Wide-field contact fundus photograph of an infant:
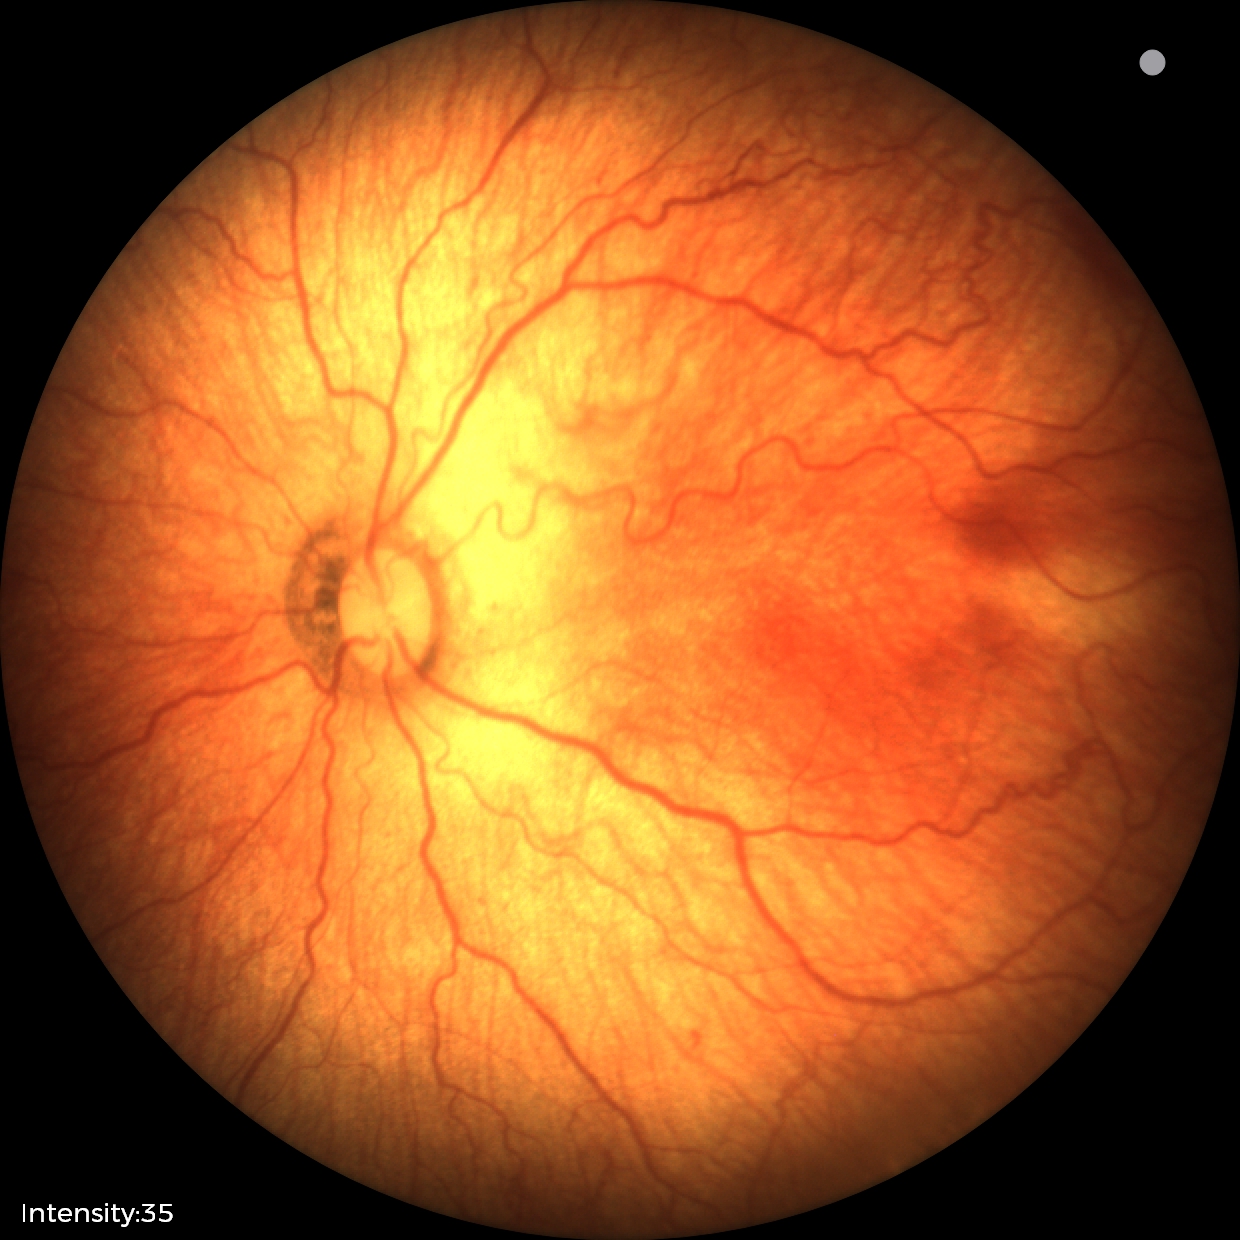
Impression: ROP stage 1, plus disease: present.